CFP; 45 degree fundus photograph:
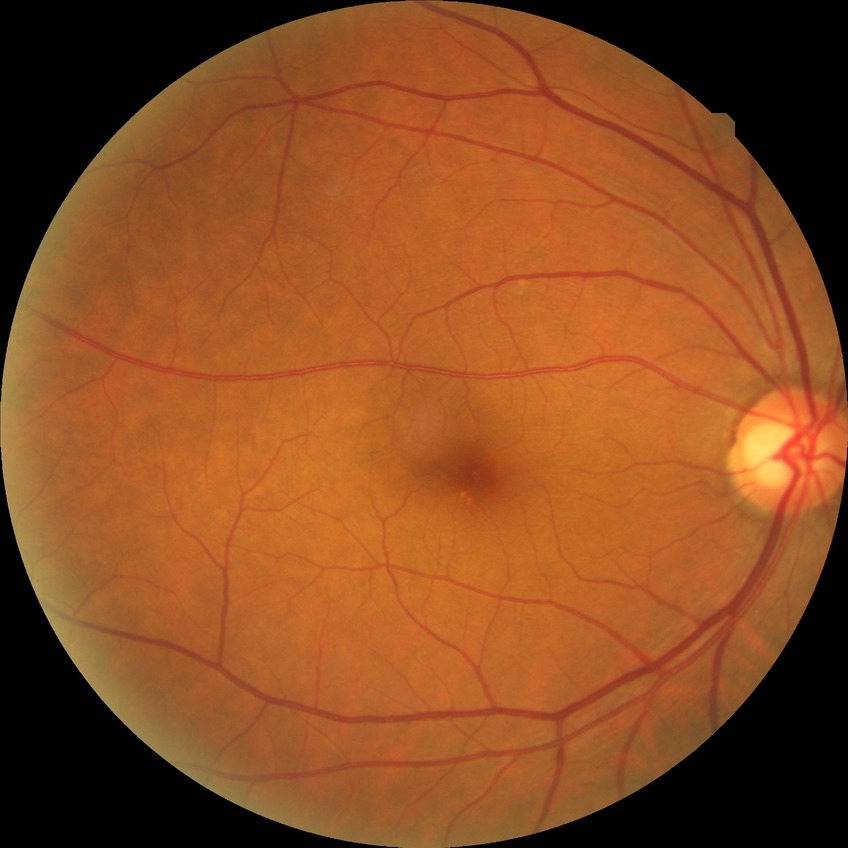
Davis DR grade@NDR.